Optic nerve head photograph: 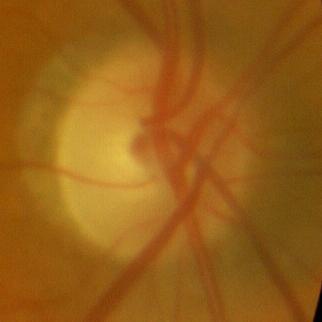
Glaucoma assessment = no glaucomatous optic neuropathy.